Acquired on the Clarity RetCam 3; pediatric wide-field fundus photograph; 640 by 480 pixels
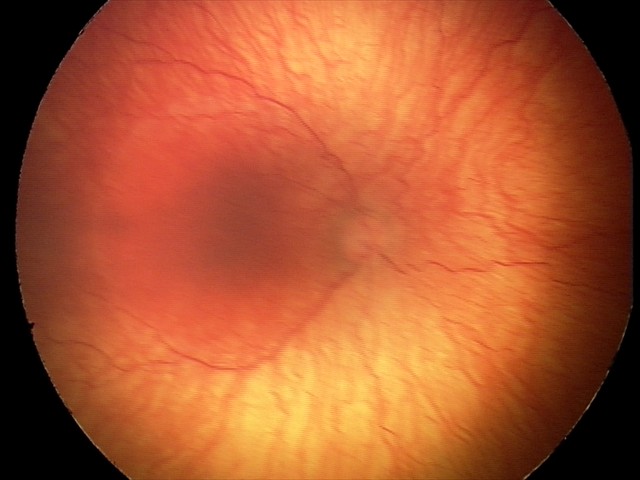

Screening: plus disease | A-ROP (aggressive ROP).